Retinal fundus photograph, 848x848px
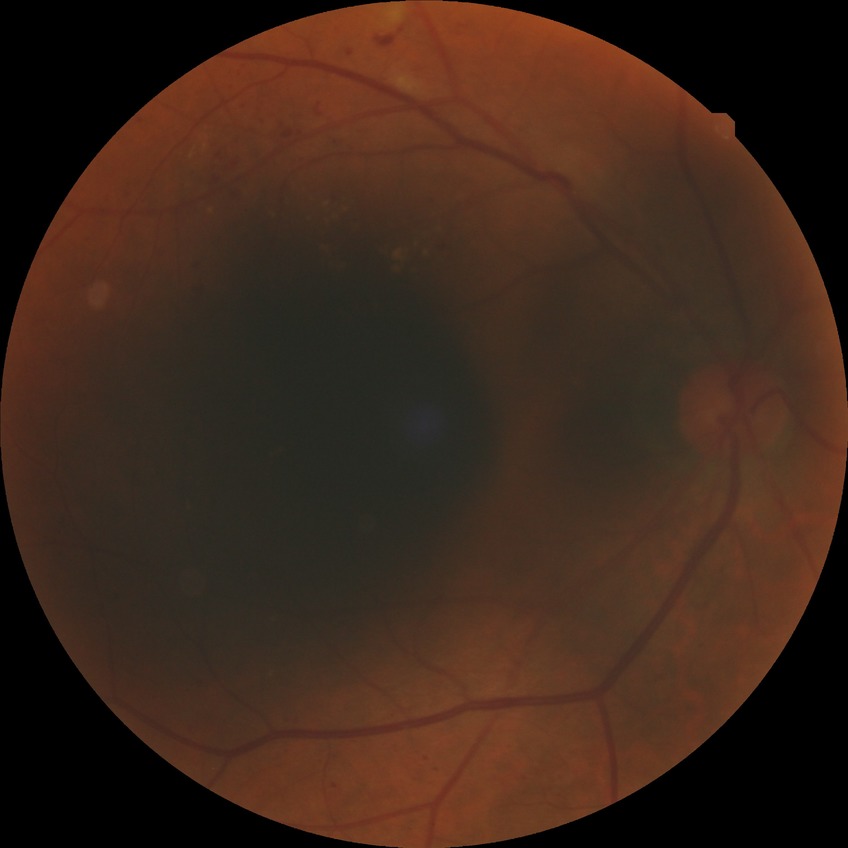

{"davis_grade": "SDR"}